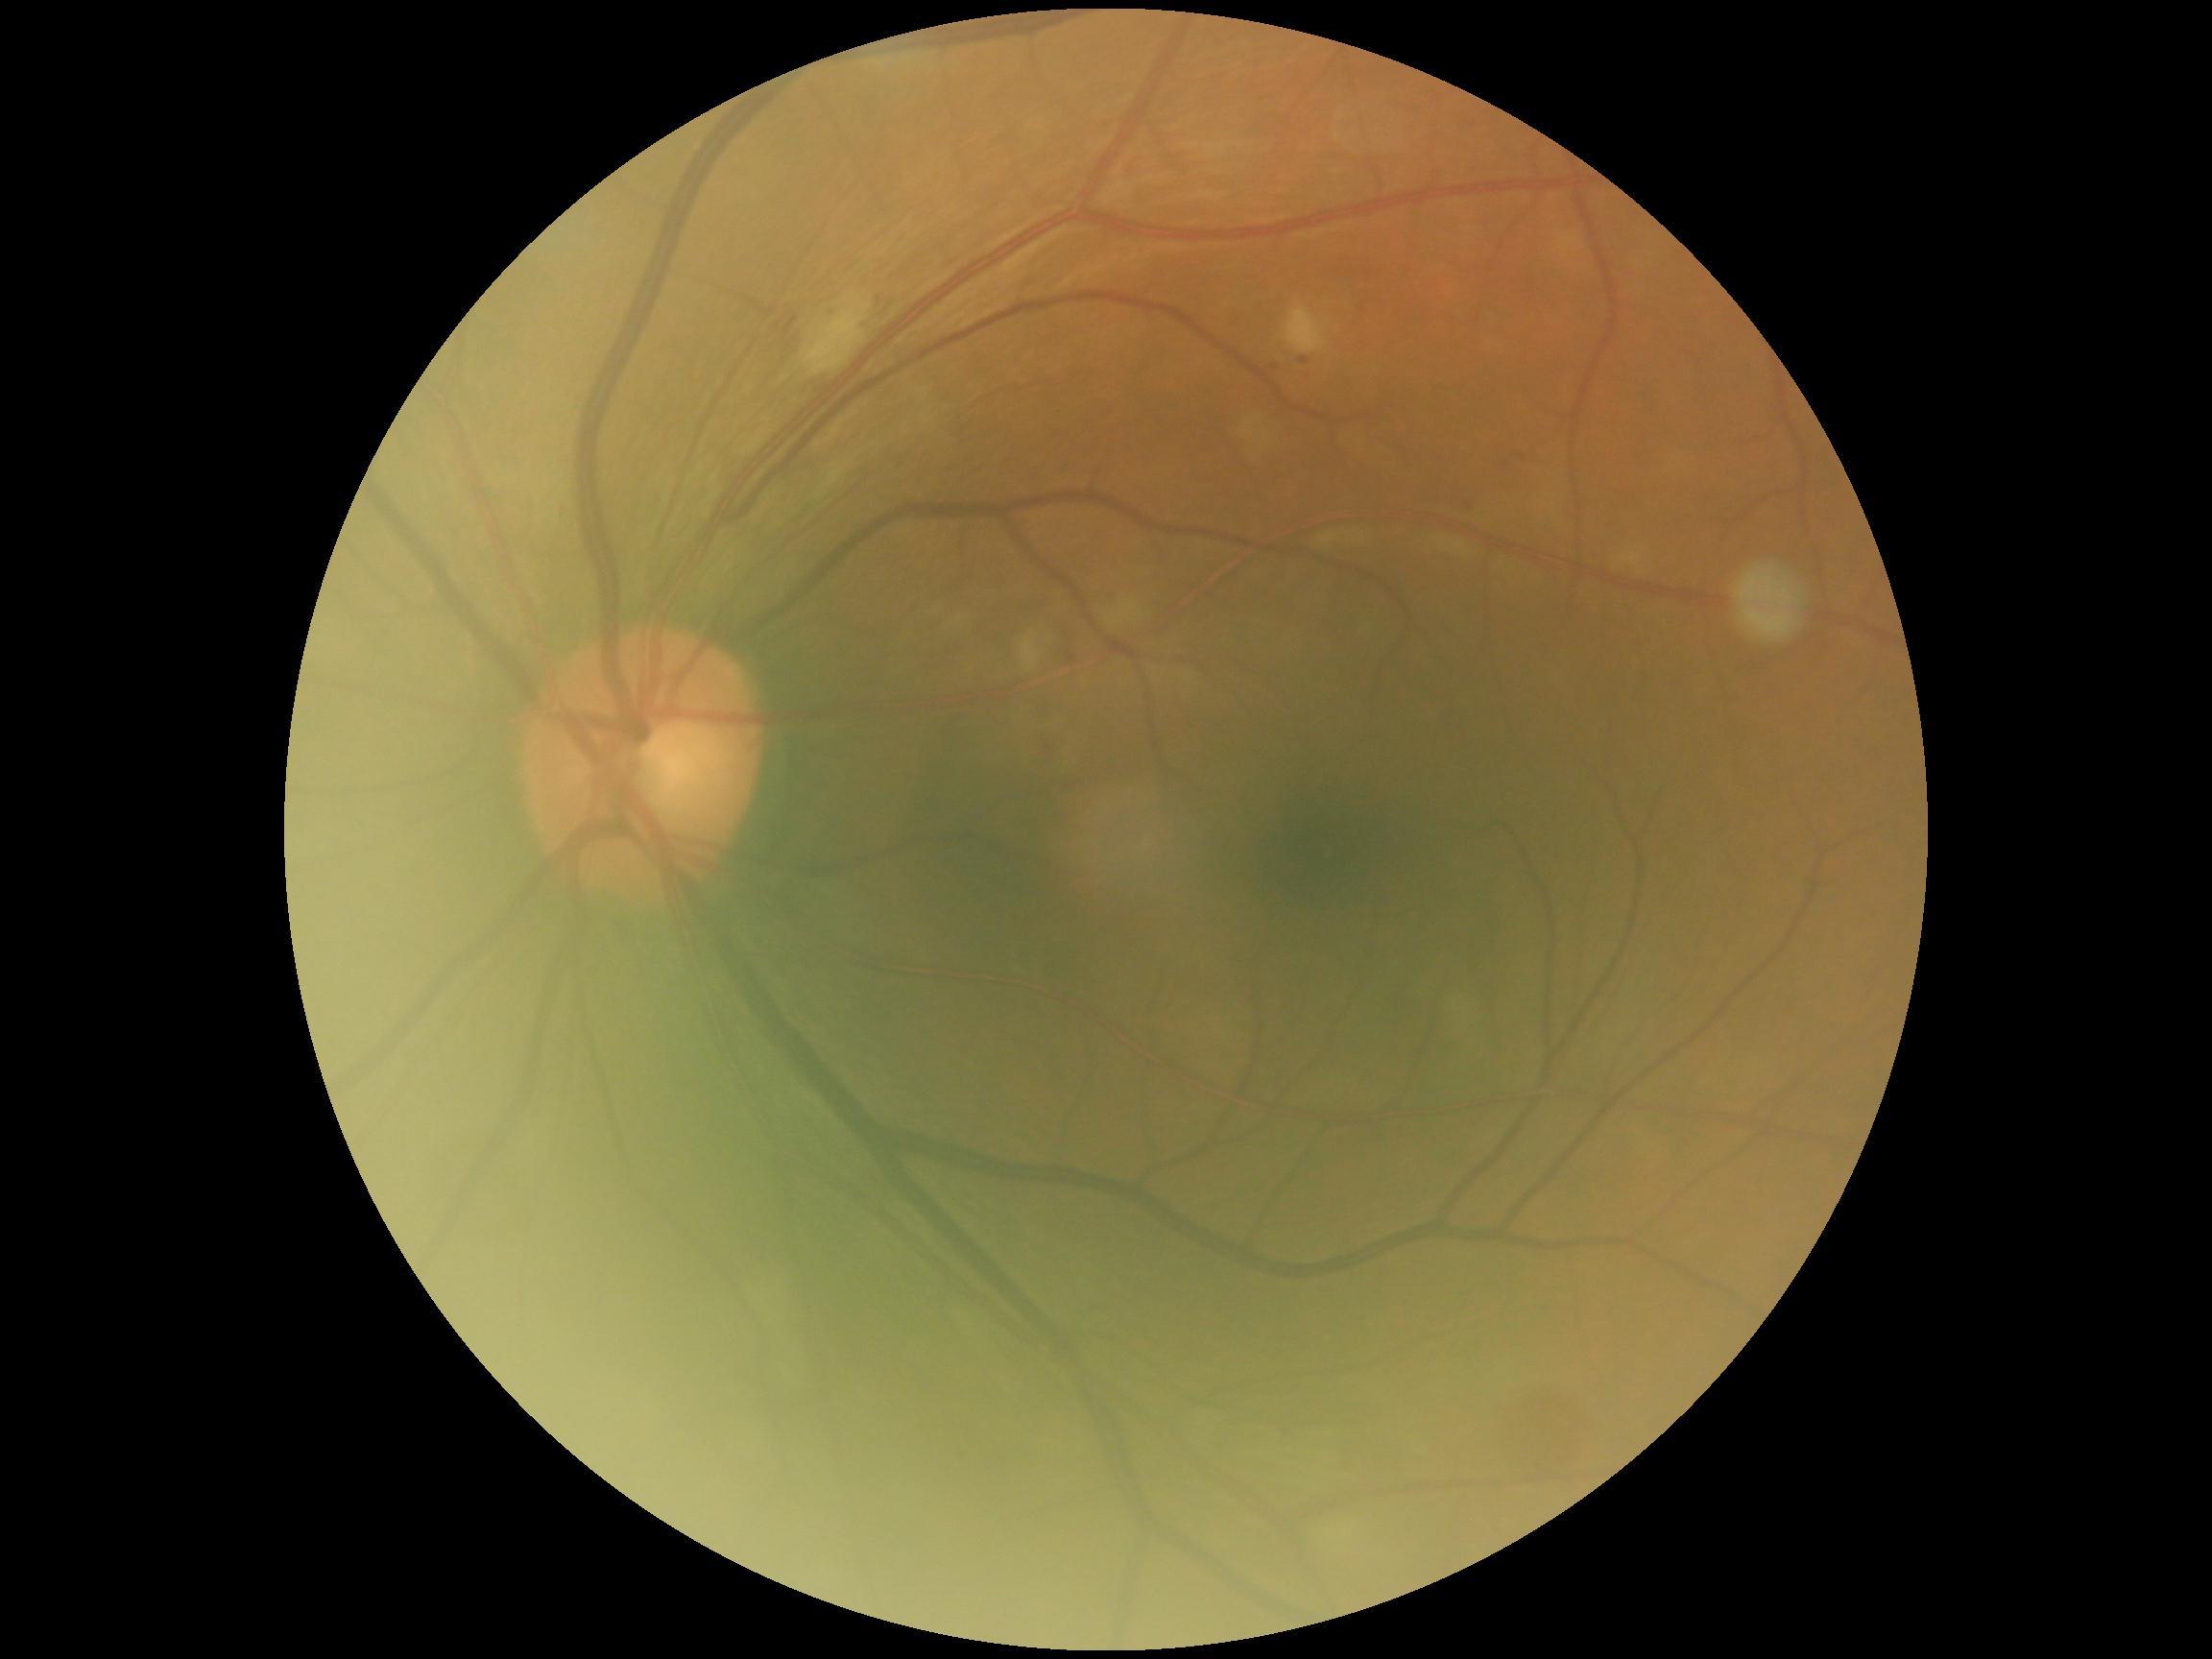
DR: 2 — more than just microaneurysms but less than severe NPDR.
The retinopathy is classified as non-proliferative diabetic retinopathy.